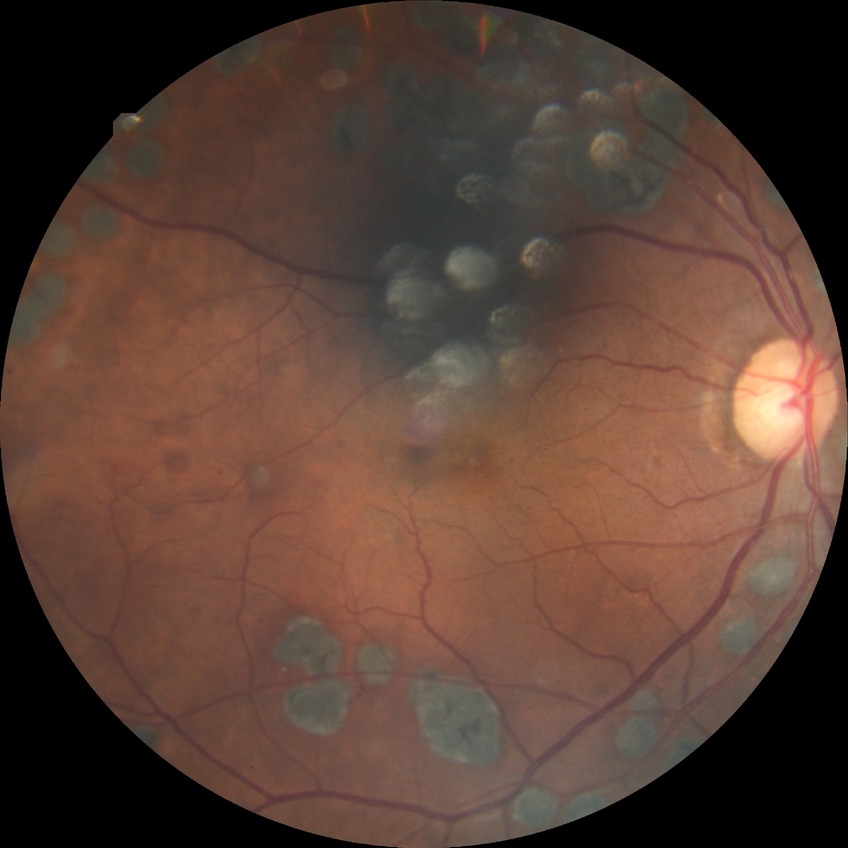
DR stage is PDR.